DR severity per modified Davis staging
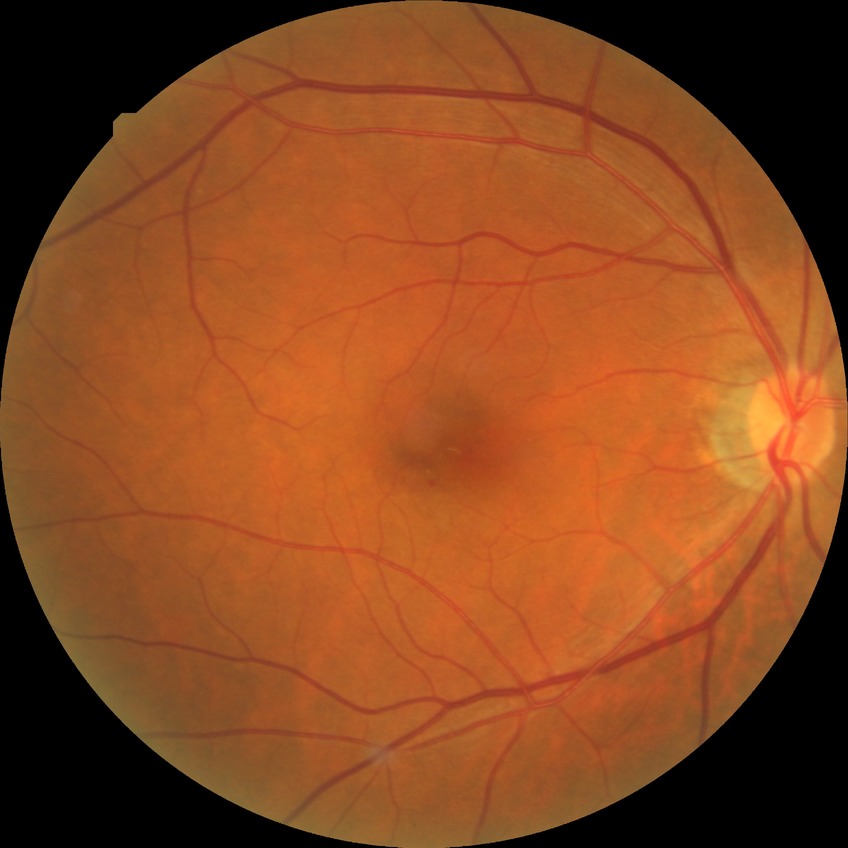
Diabetic retinopathy severity: no diabetic retinopathy.